Wide-field contact fundus photograph of an infant
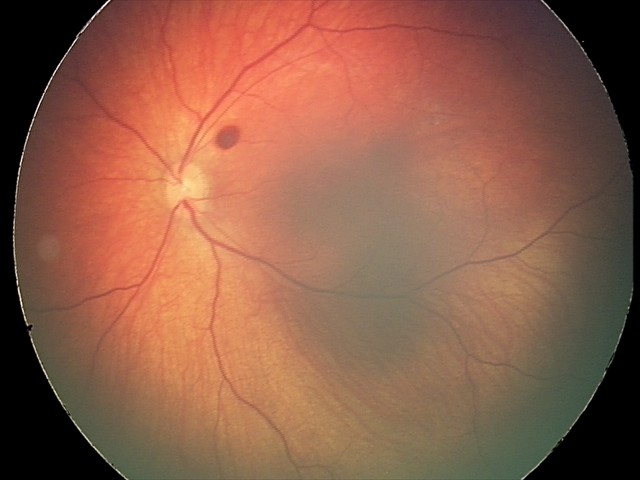
From an examination with diagnosis of retinal hemorrhages.